Pediatric wide-field fundus photograph. 1240 x 1240 pixels
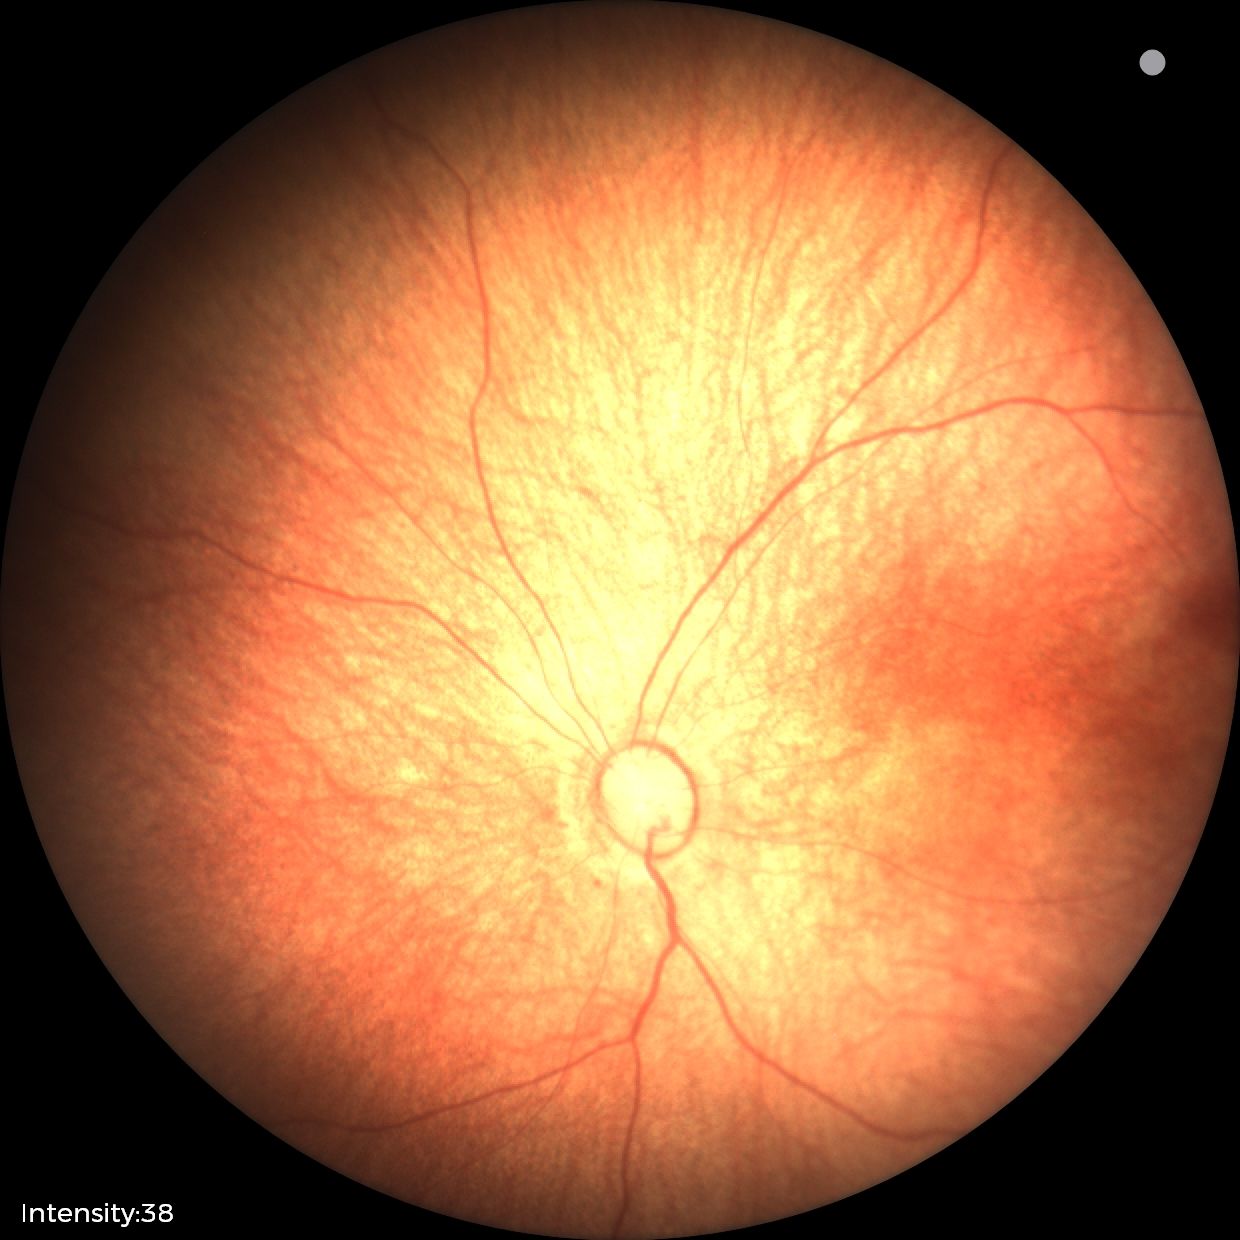
No retinal pathology identified on screening.